Infant wide-field retinal image — 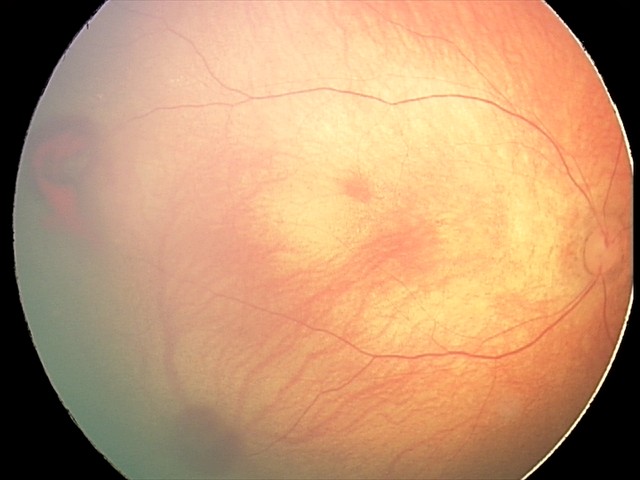 Screening diagnosis: retinal hemorrhages.